Camera: Bosch handheld camera: 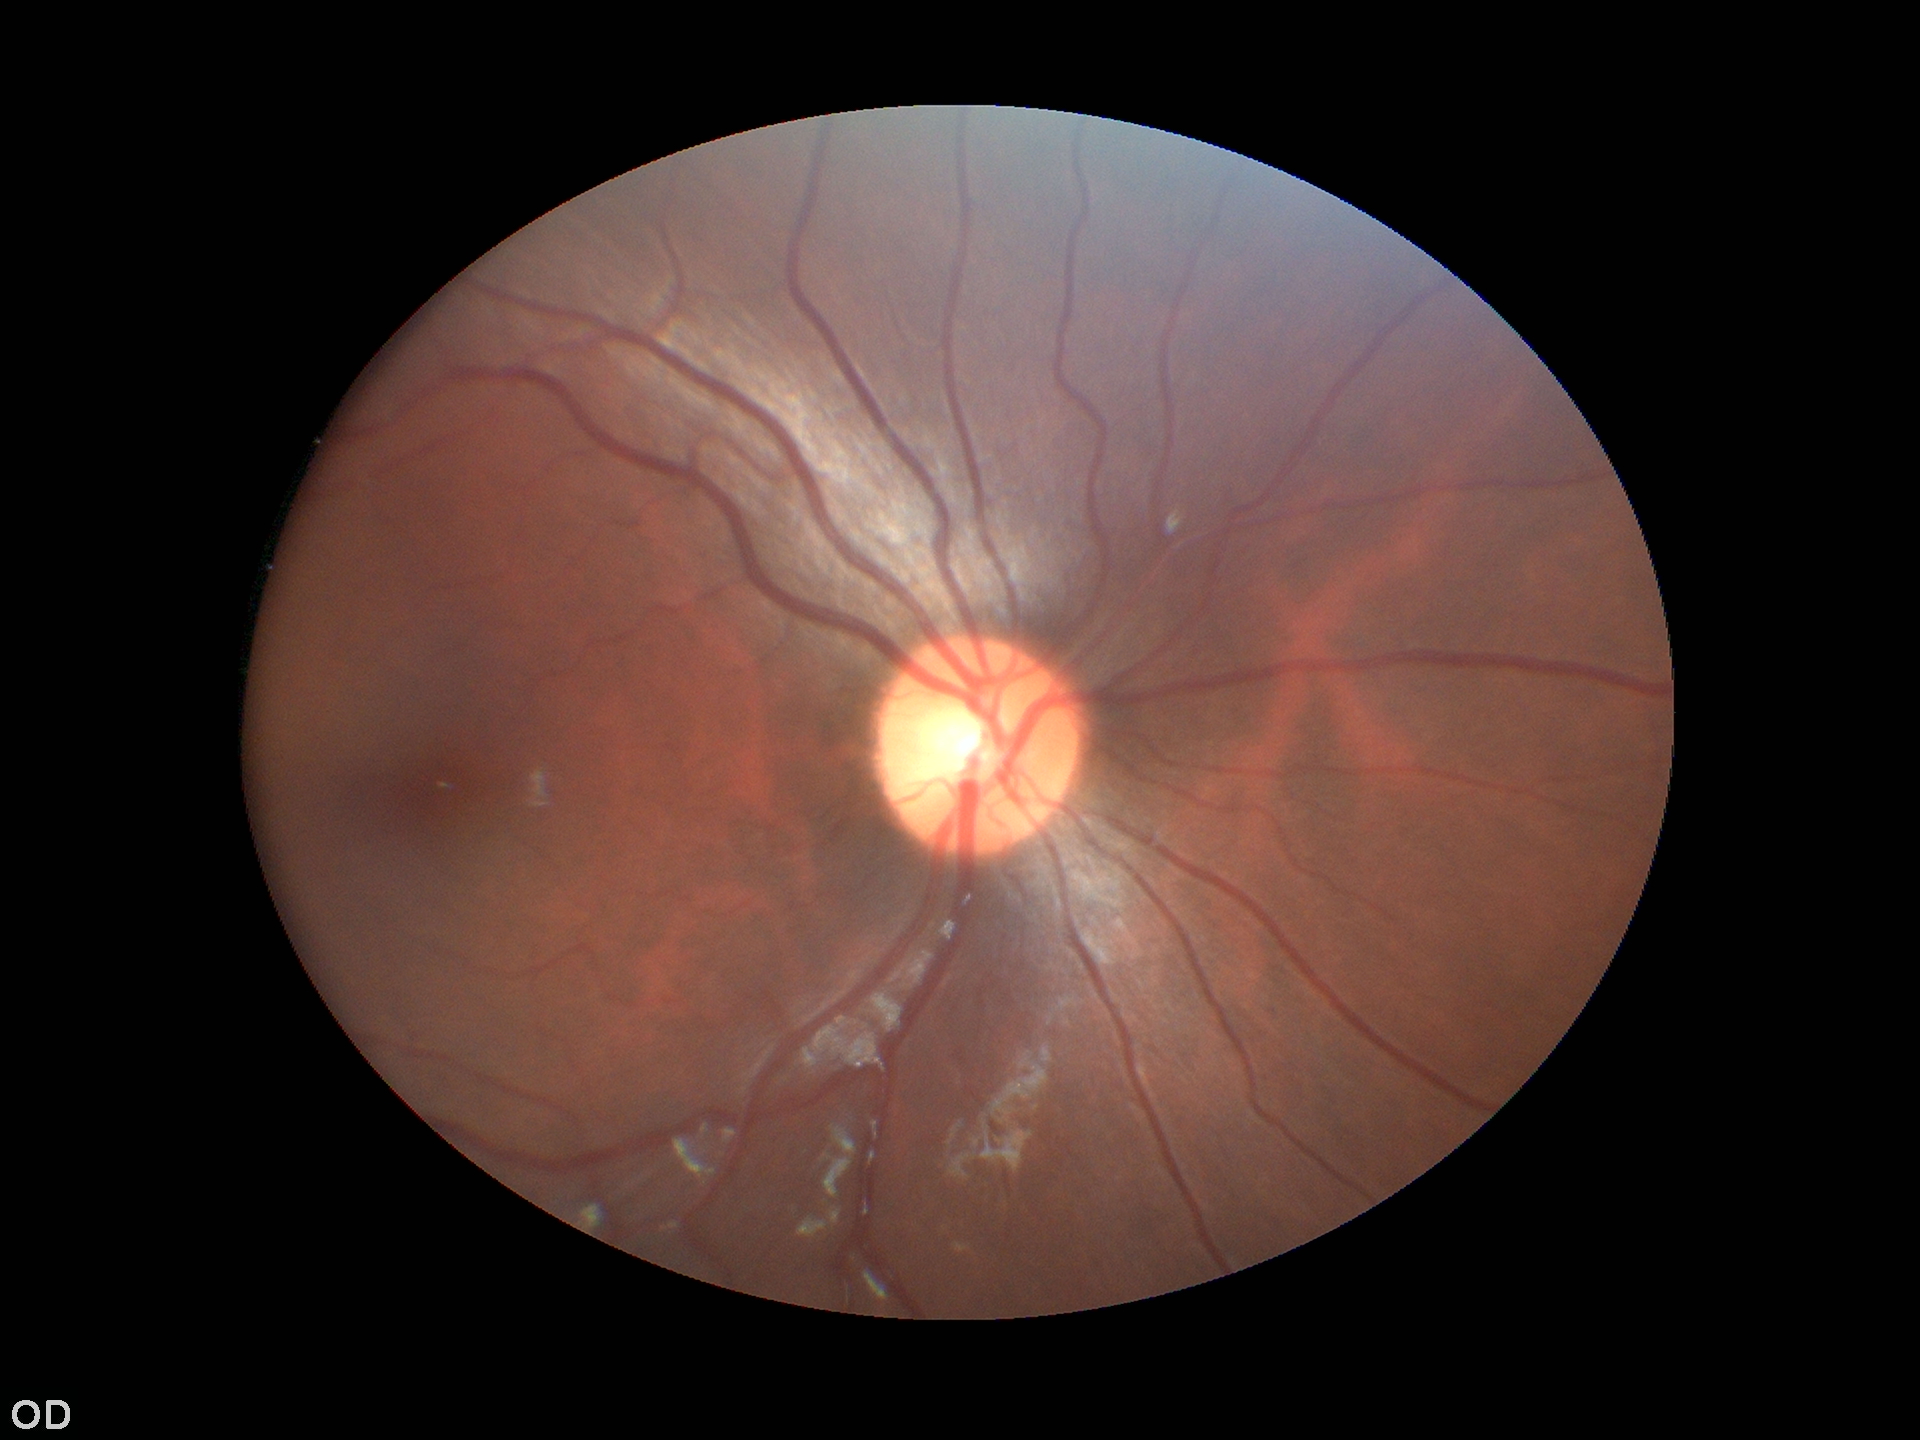 Glaucoma impression: no suspicious findings (5/5 ophthalmologists in agreement). Vertical C/D ratio is 0.52. Horizontal CDR: 0.50.